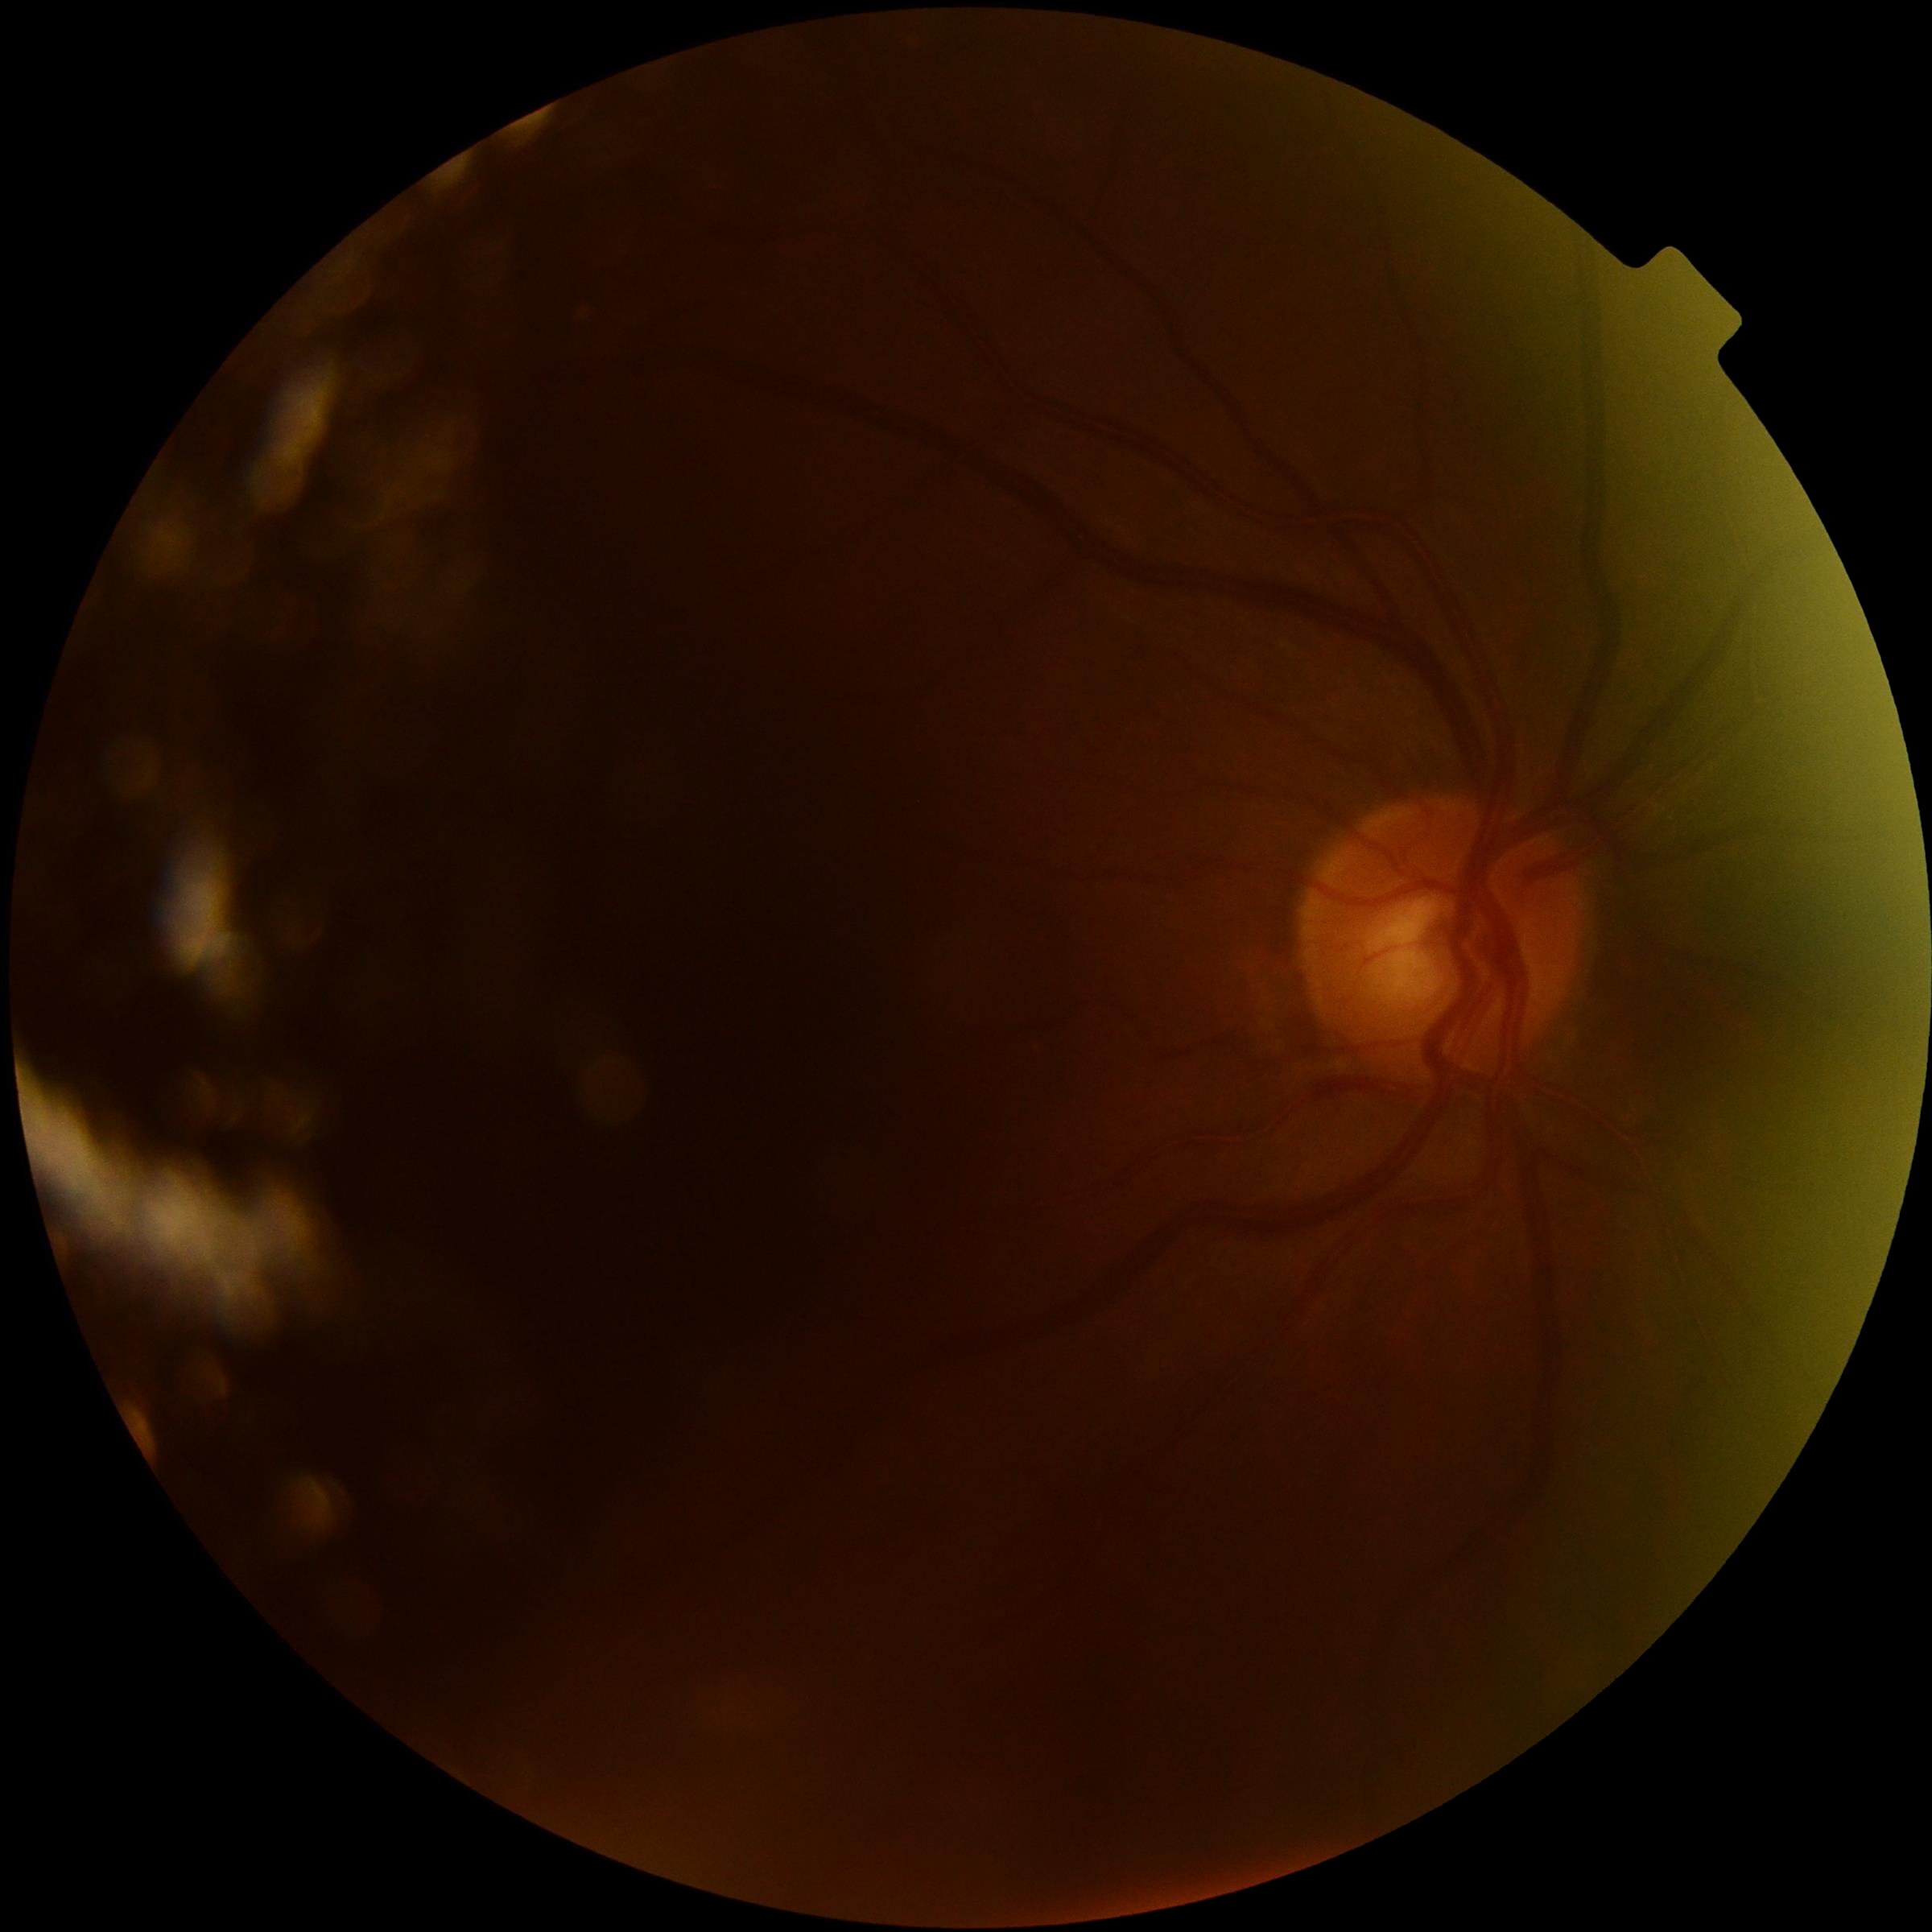

• diabetic retinopathy grade: ungradable